Pediatric retinal photograph (wide-field). 640x480.
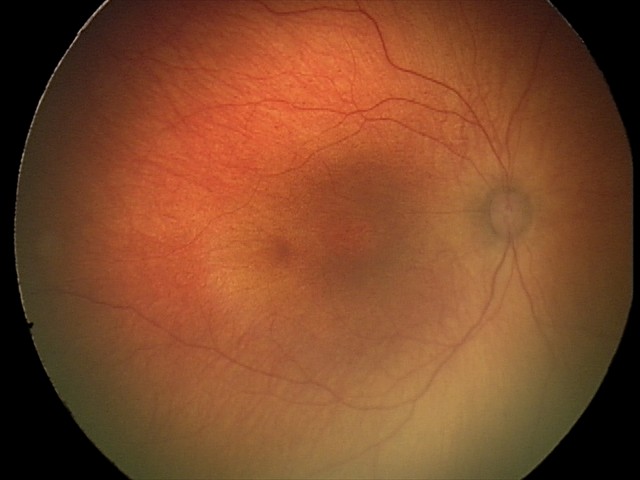

Q: What was the screening finding?
A: physiological finding